FOV: 30 degrees · non-mydriatic · 2212x1661px
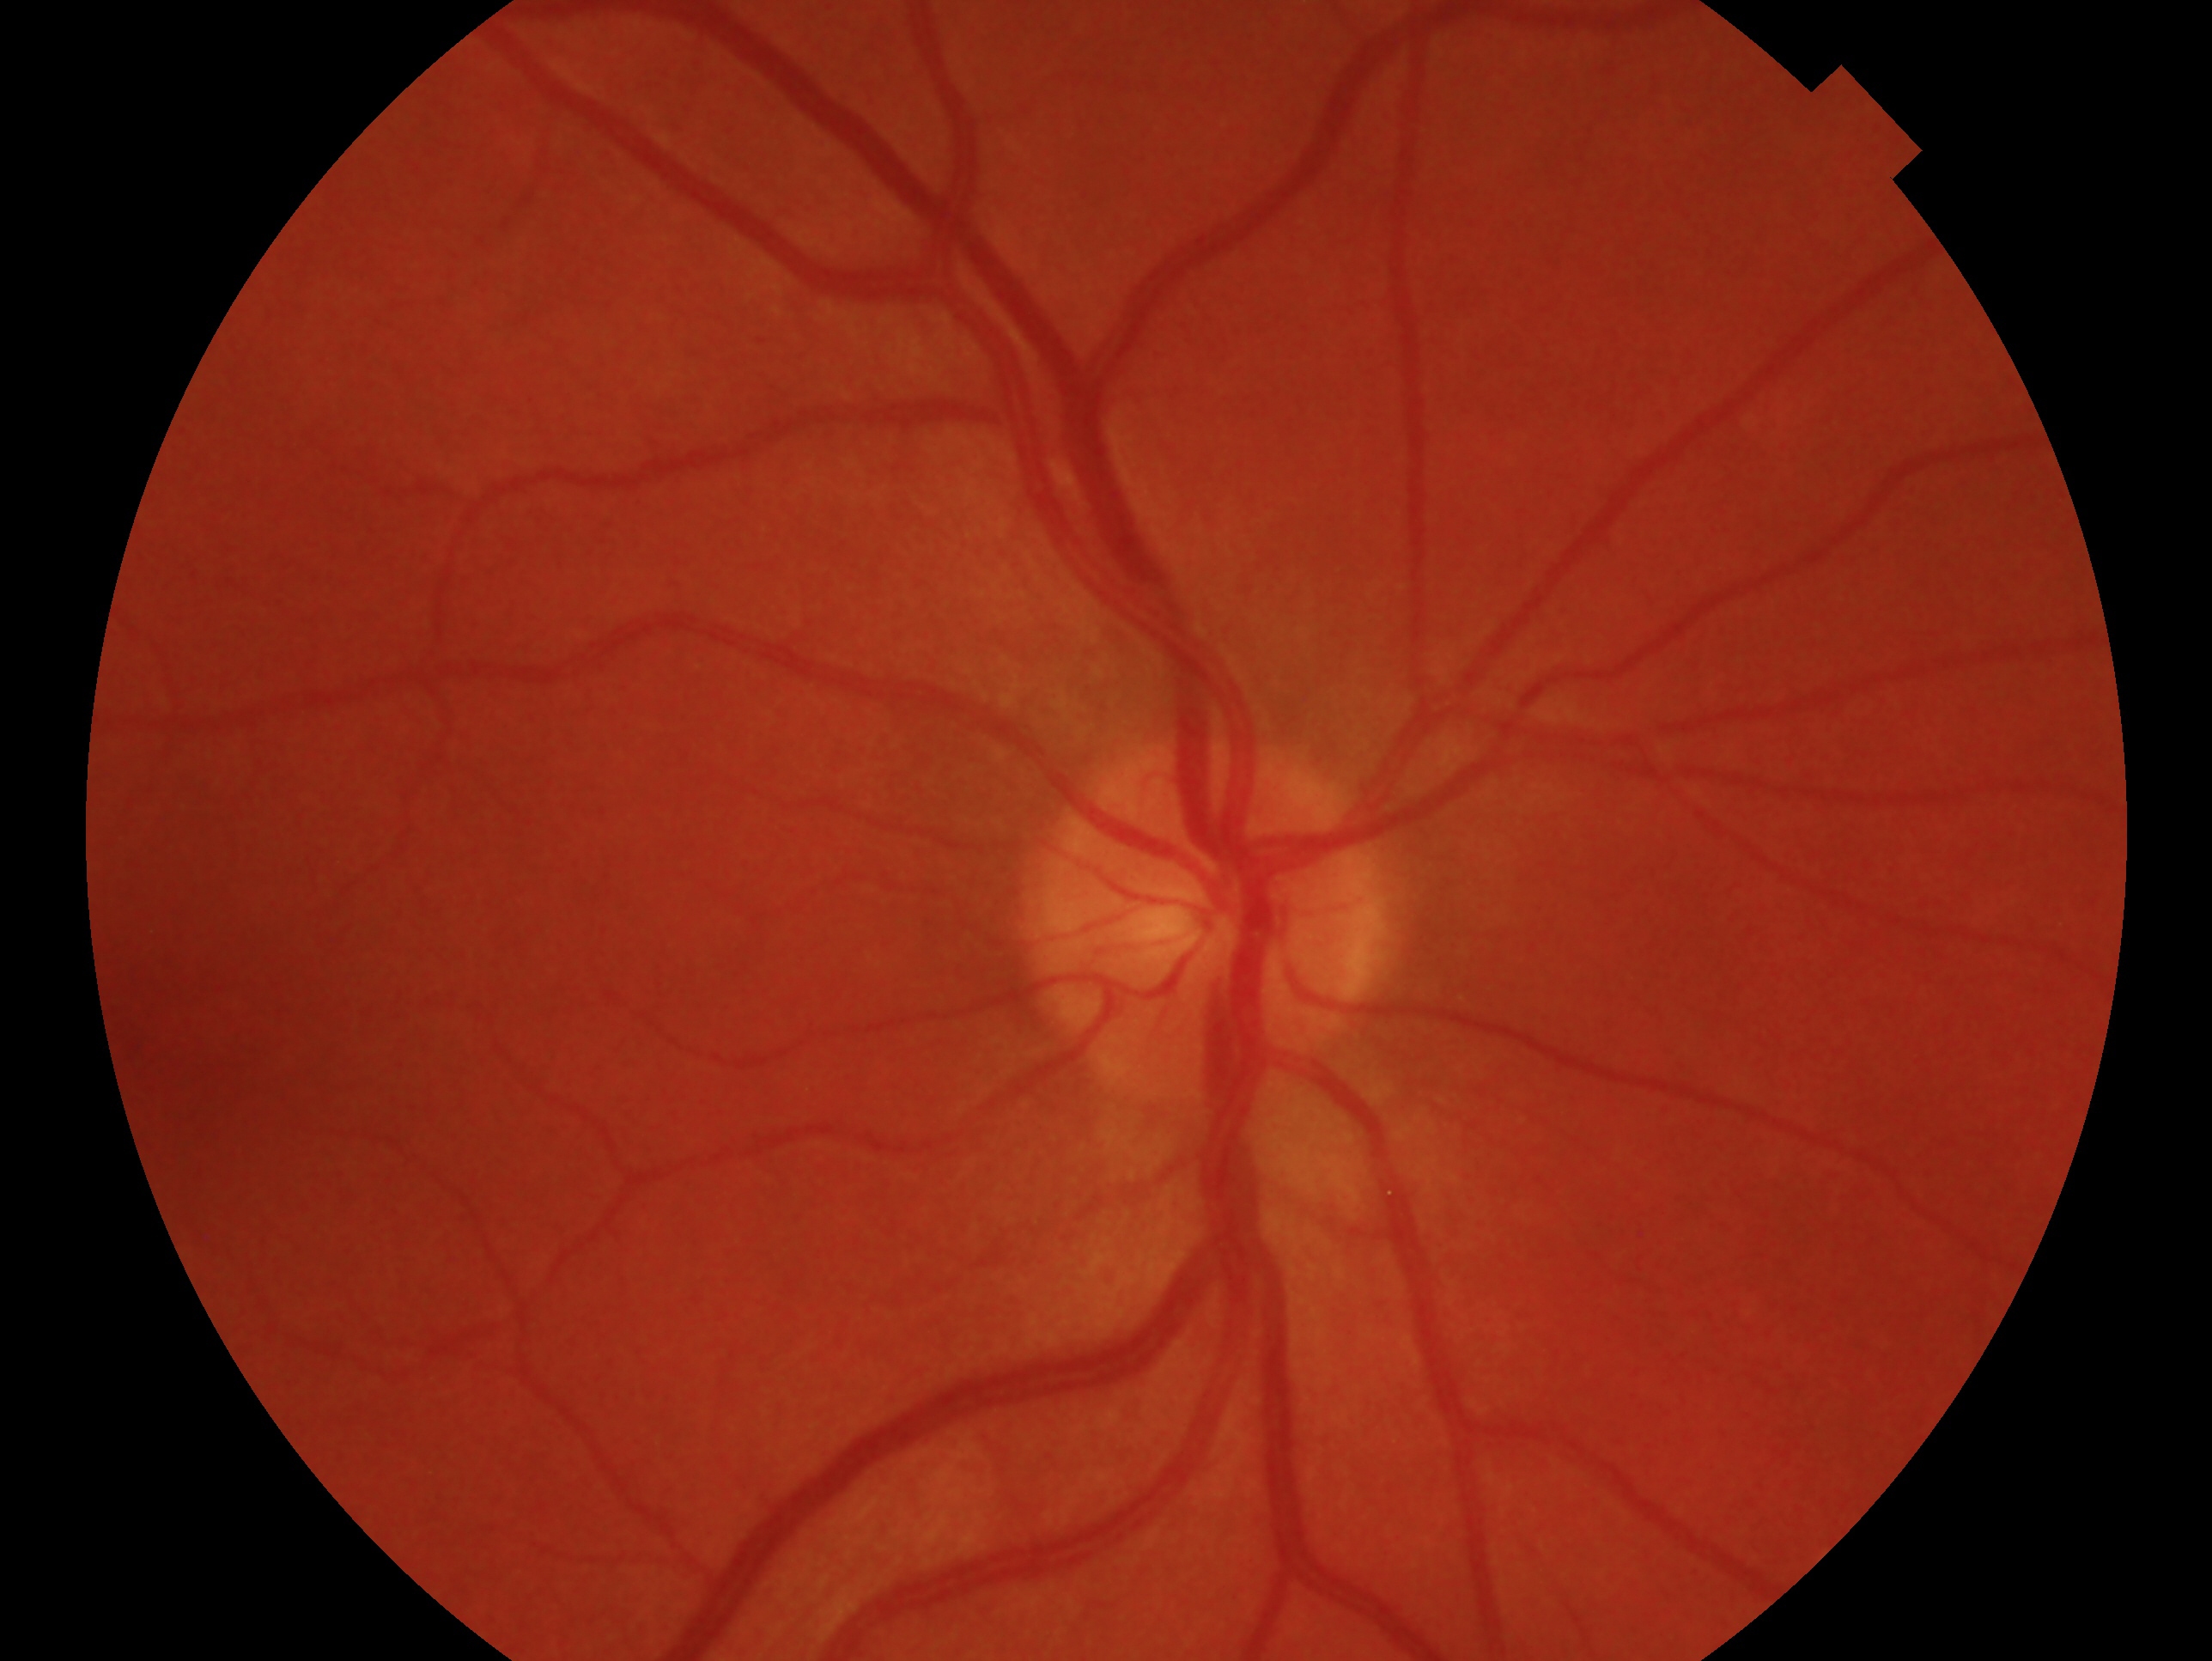 Imaged eye: OD.
Diagnosis: no glaucomatous findings — no clinical evidence of glaucoma in this eye.